2212x1672px — 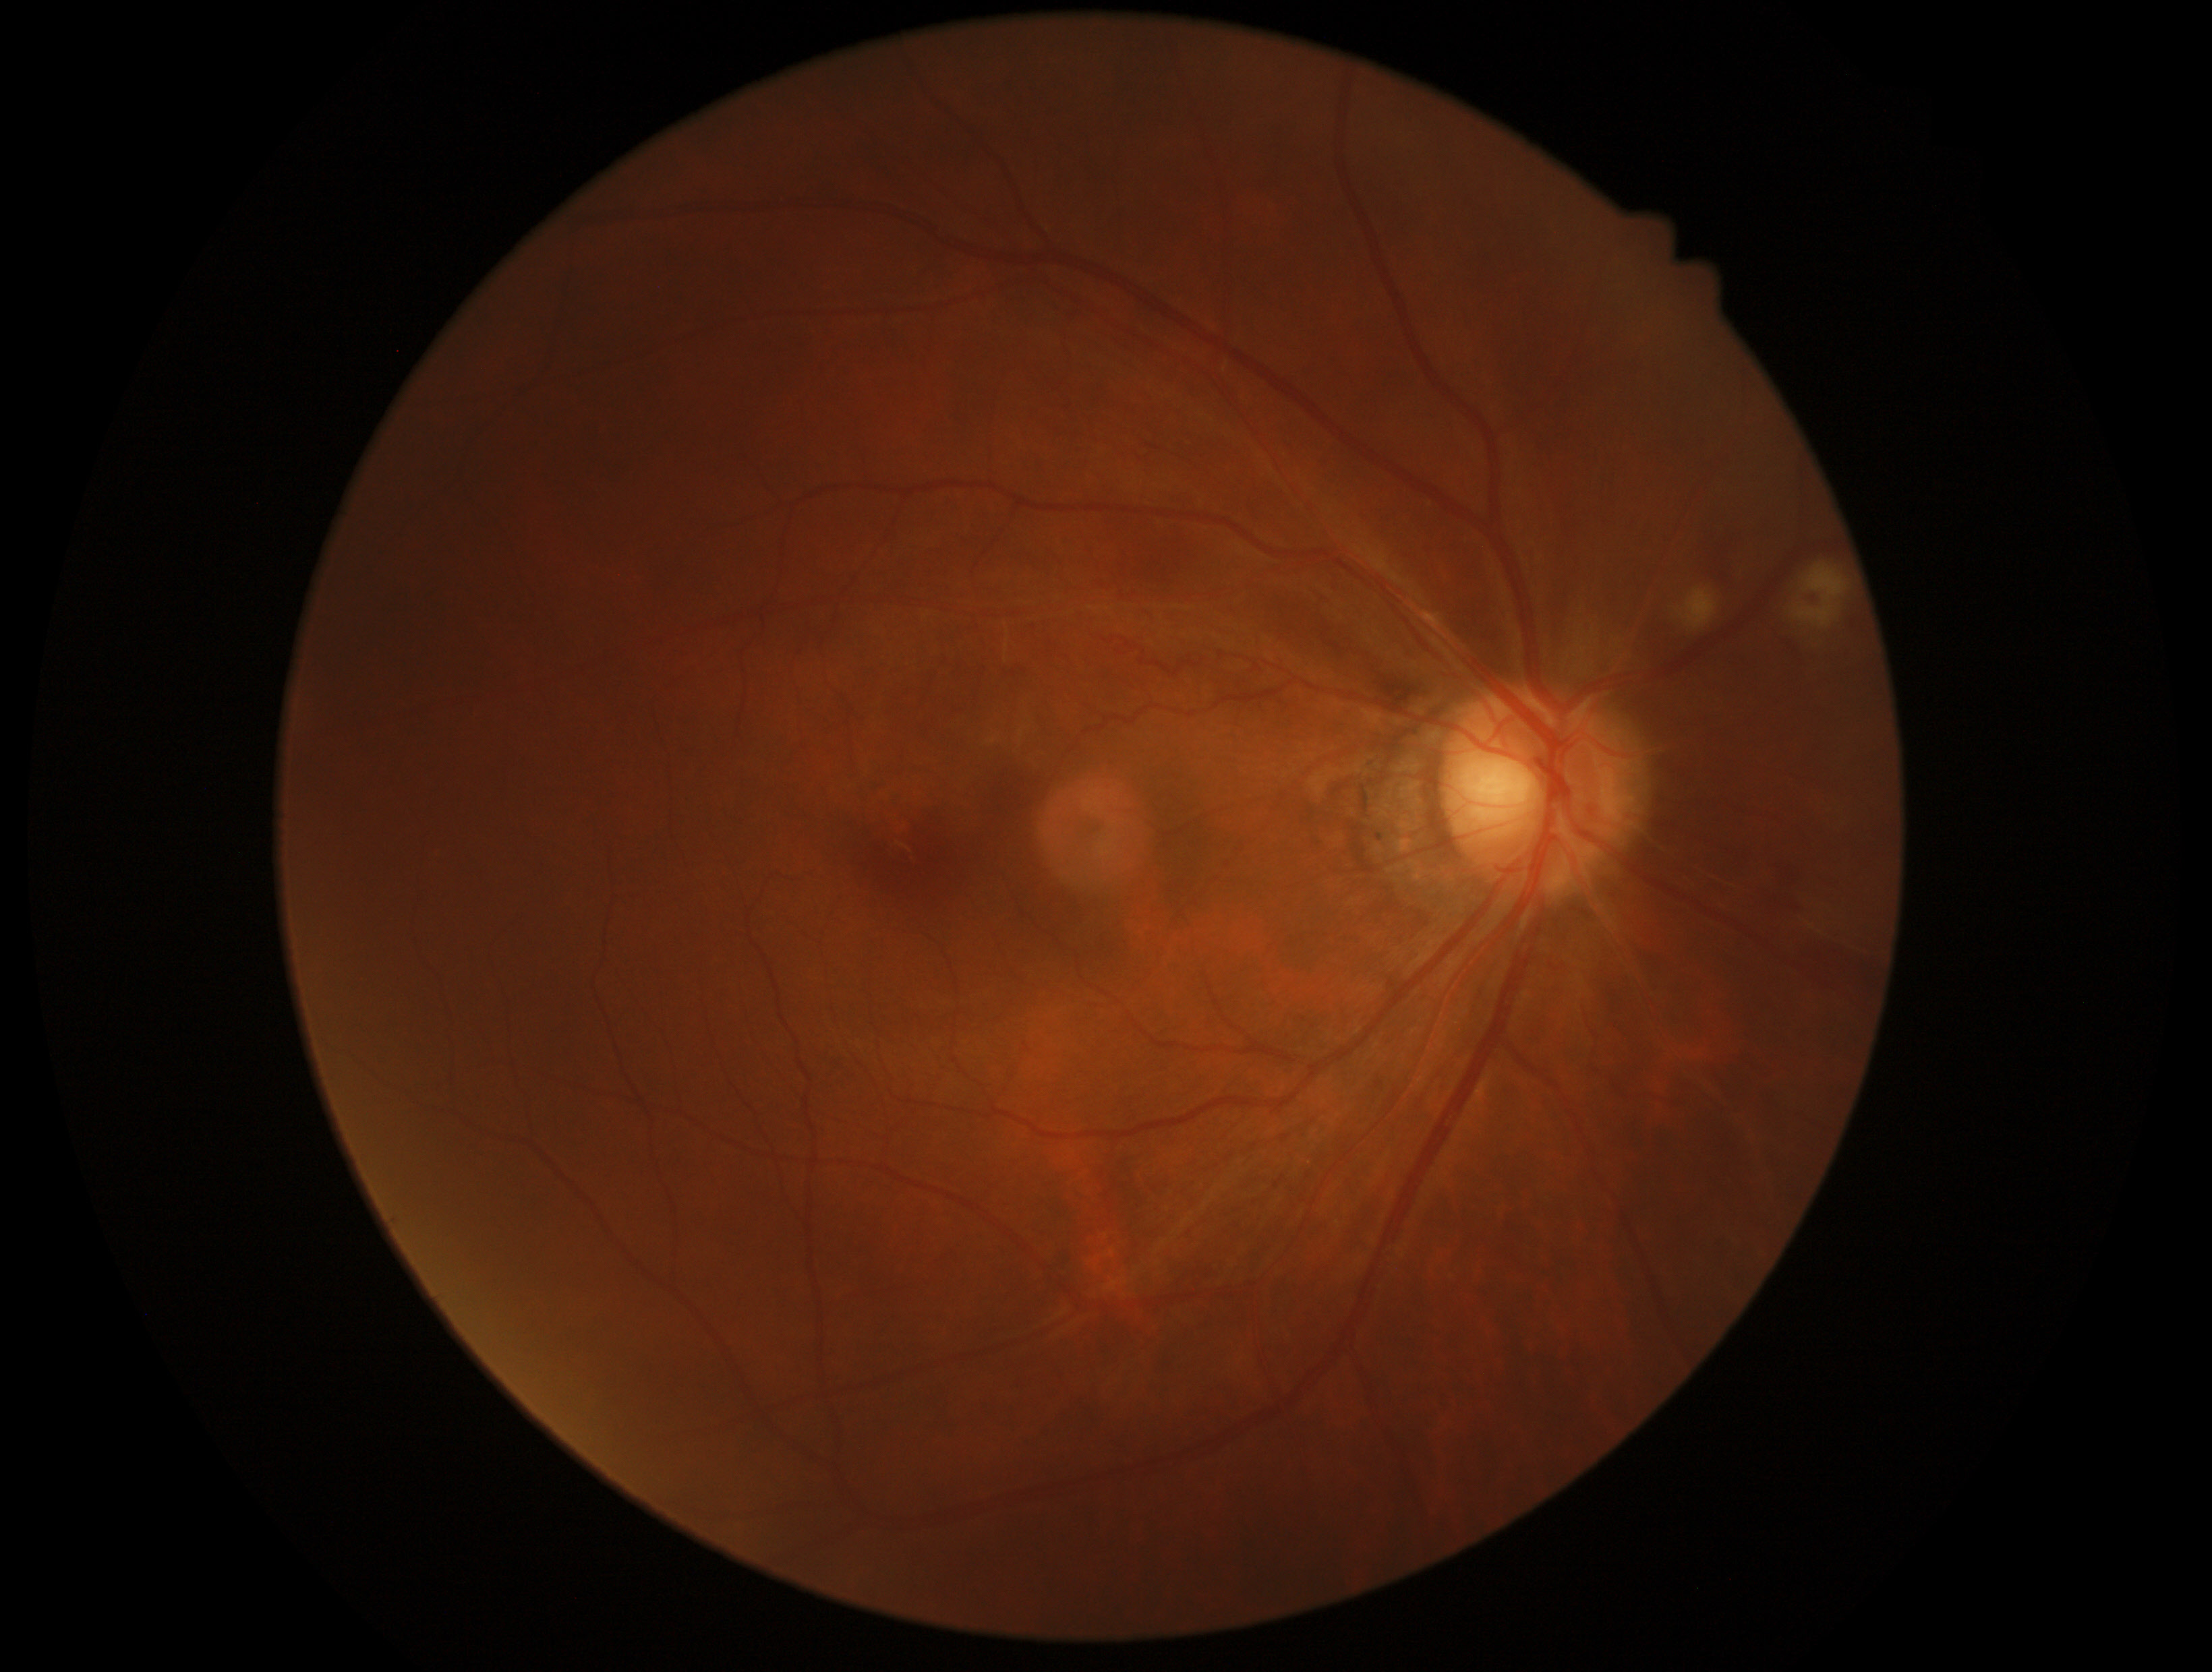 DR stage: 2.